FOV: 45 degrees. CFP. NIDEK AFC-230 fundus camera — 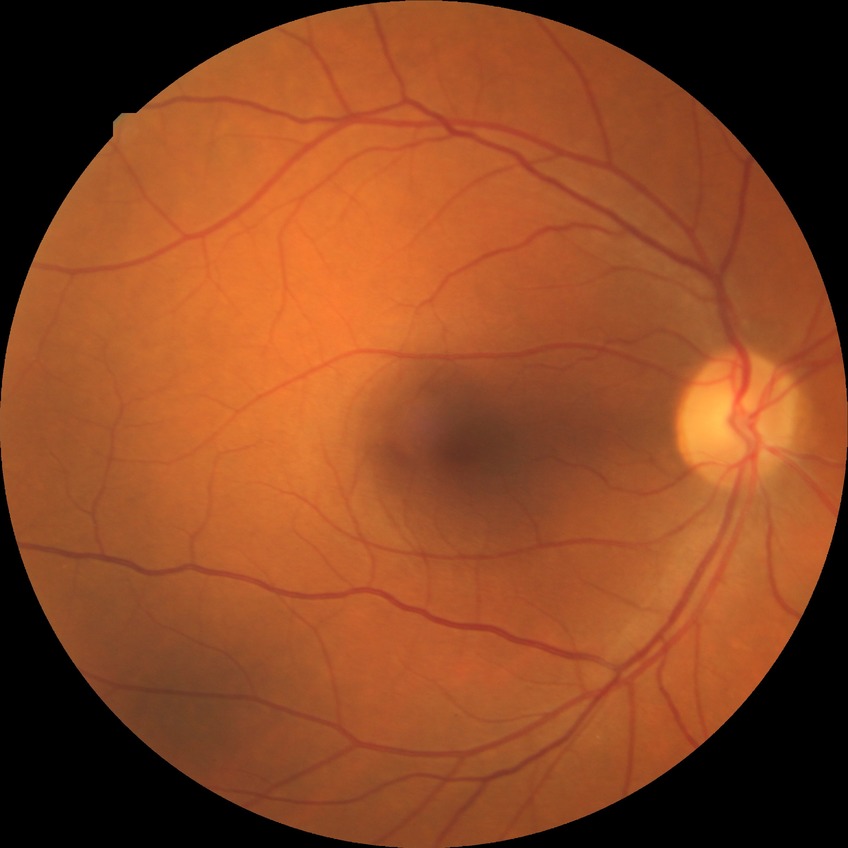

diabetic retinopathy stage=no diabetic retinopathy.